45° FOV.
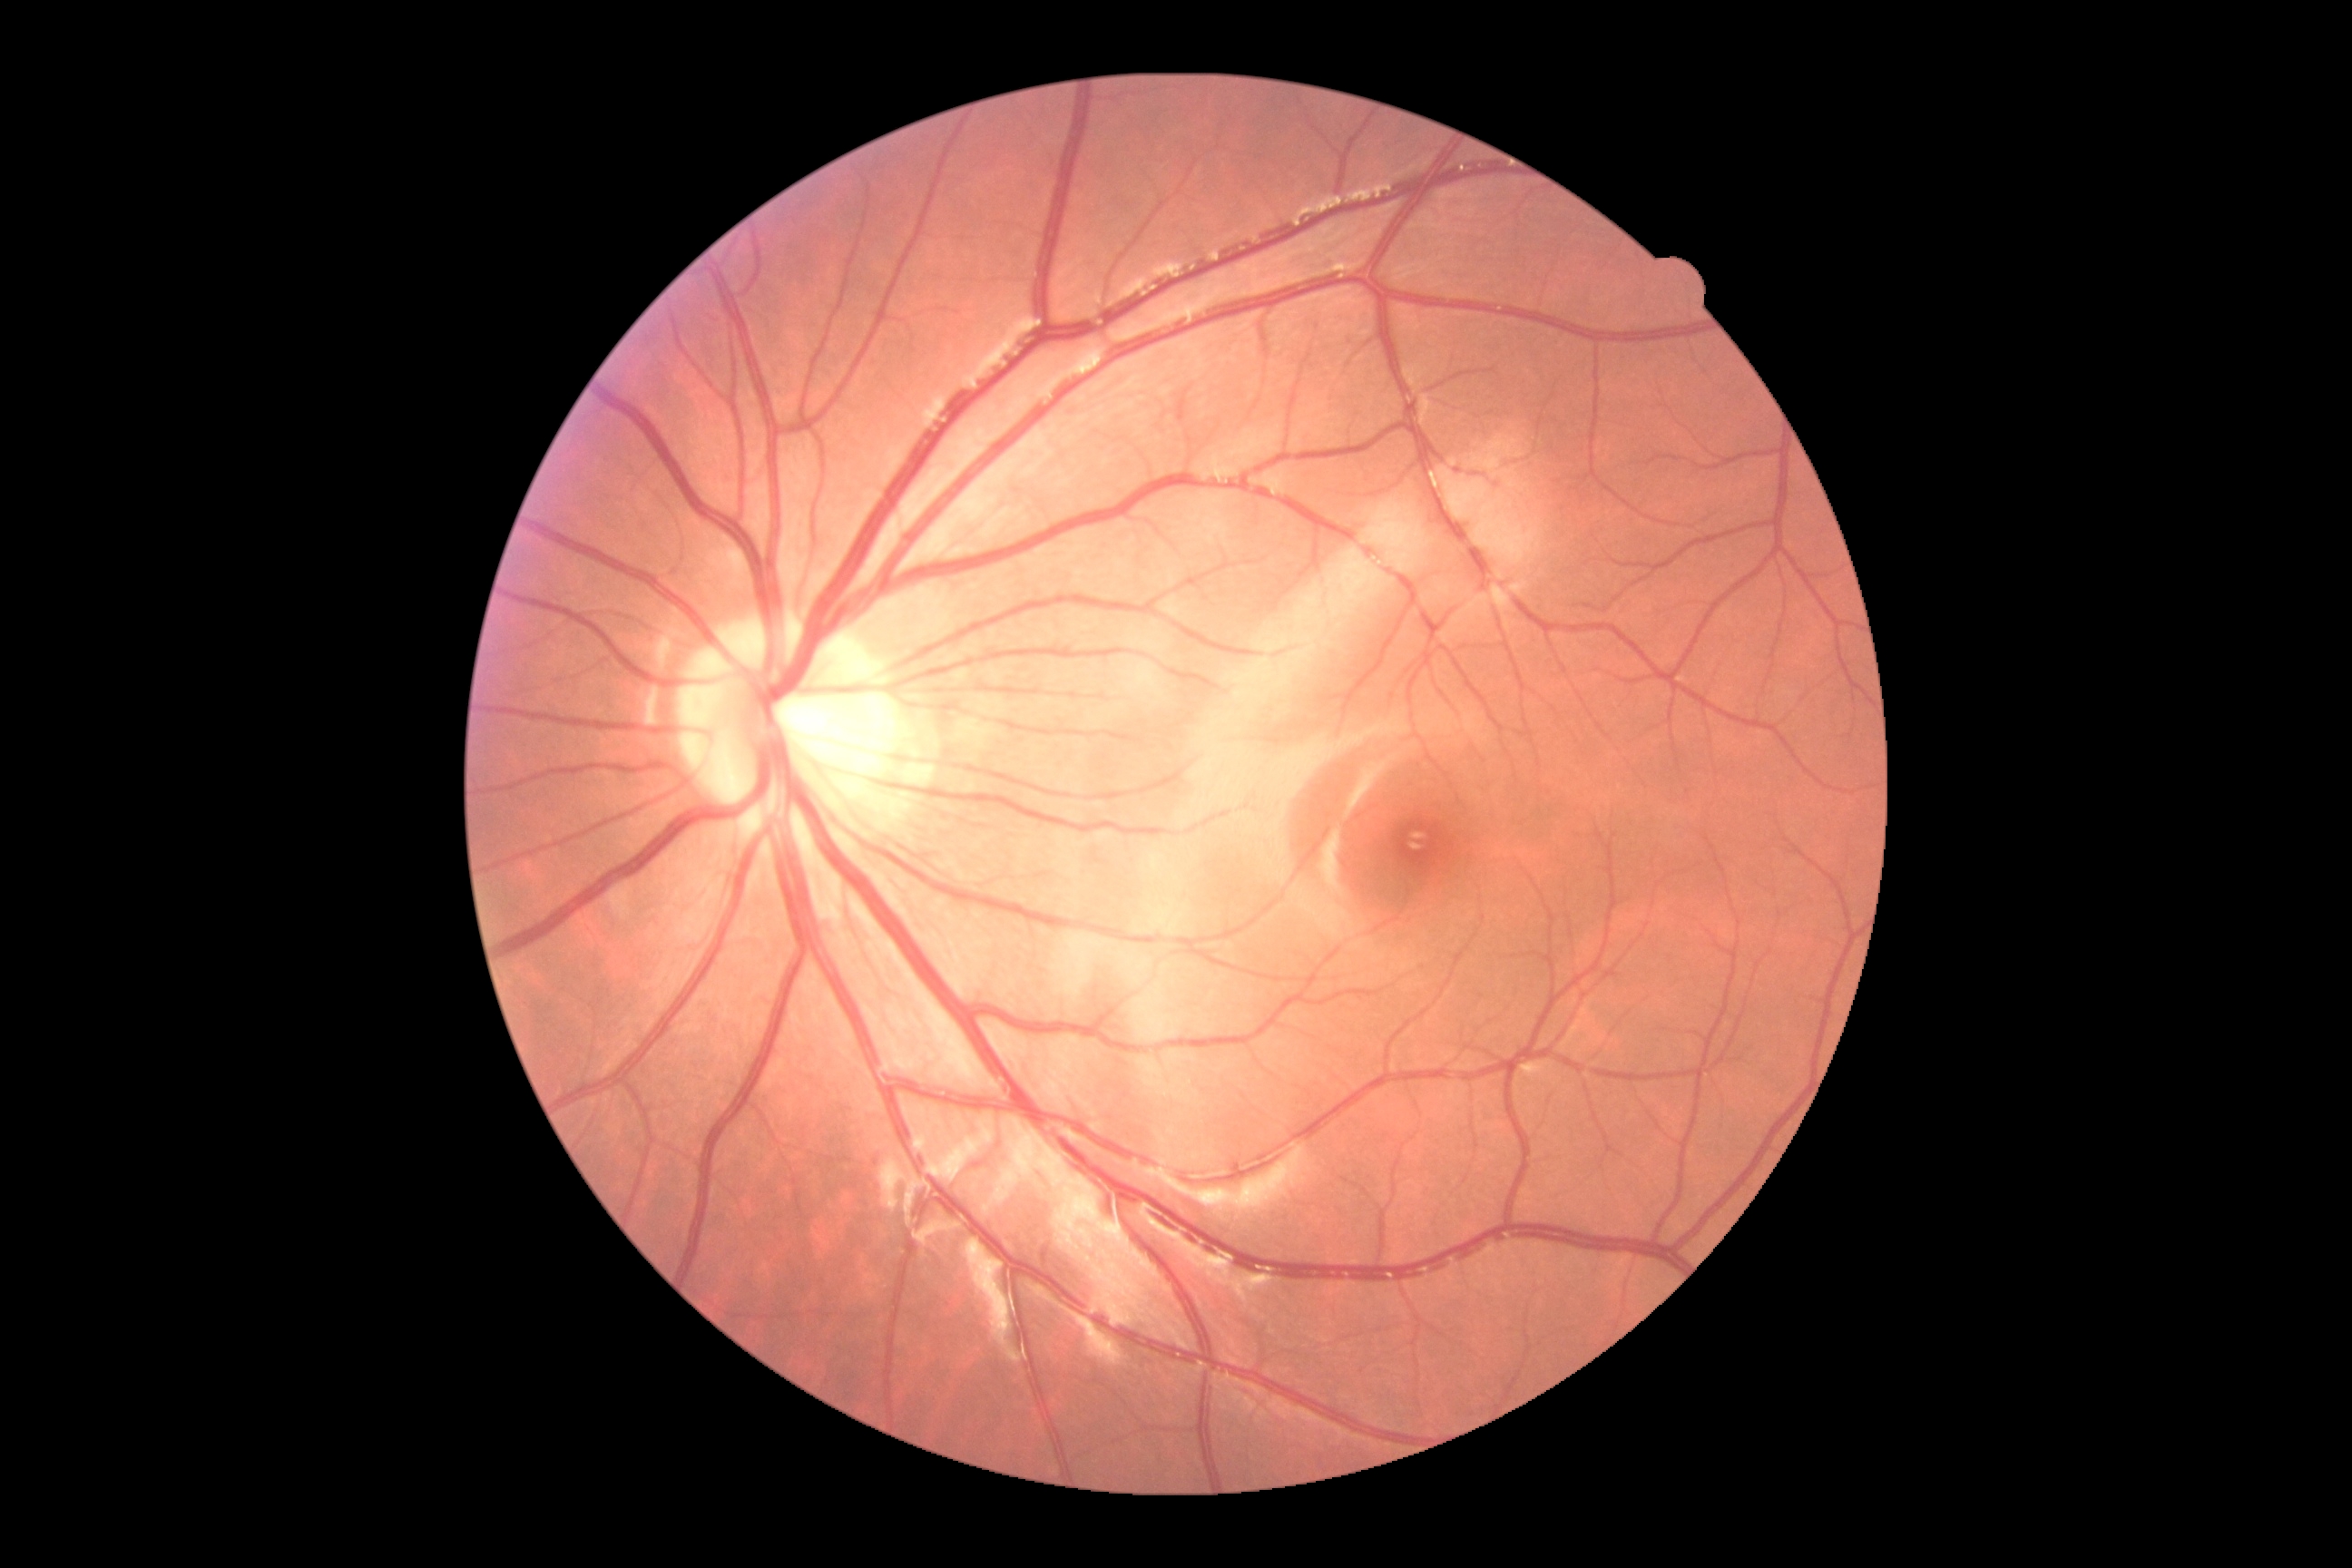 Diabetic retinopathy (DR) is grade 0 (no apparent retinopathy).